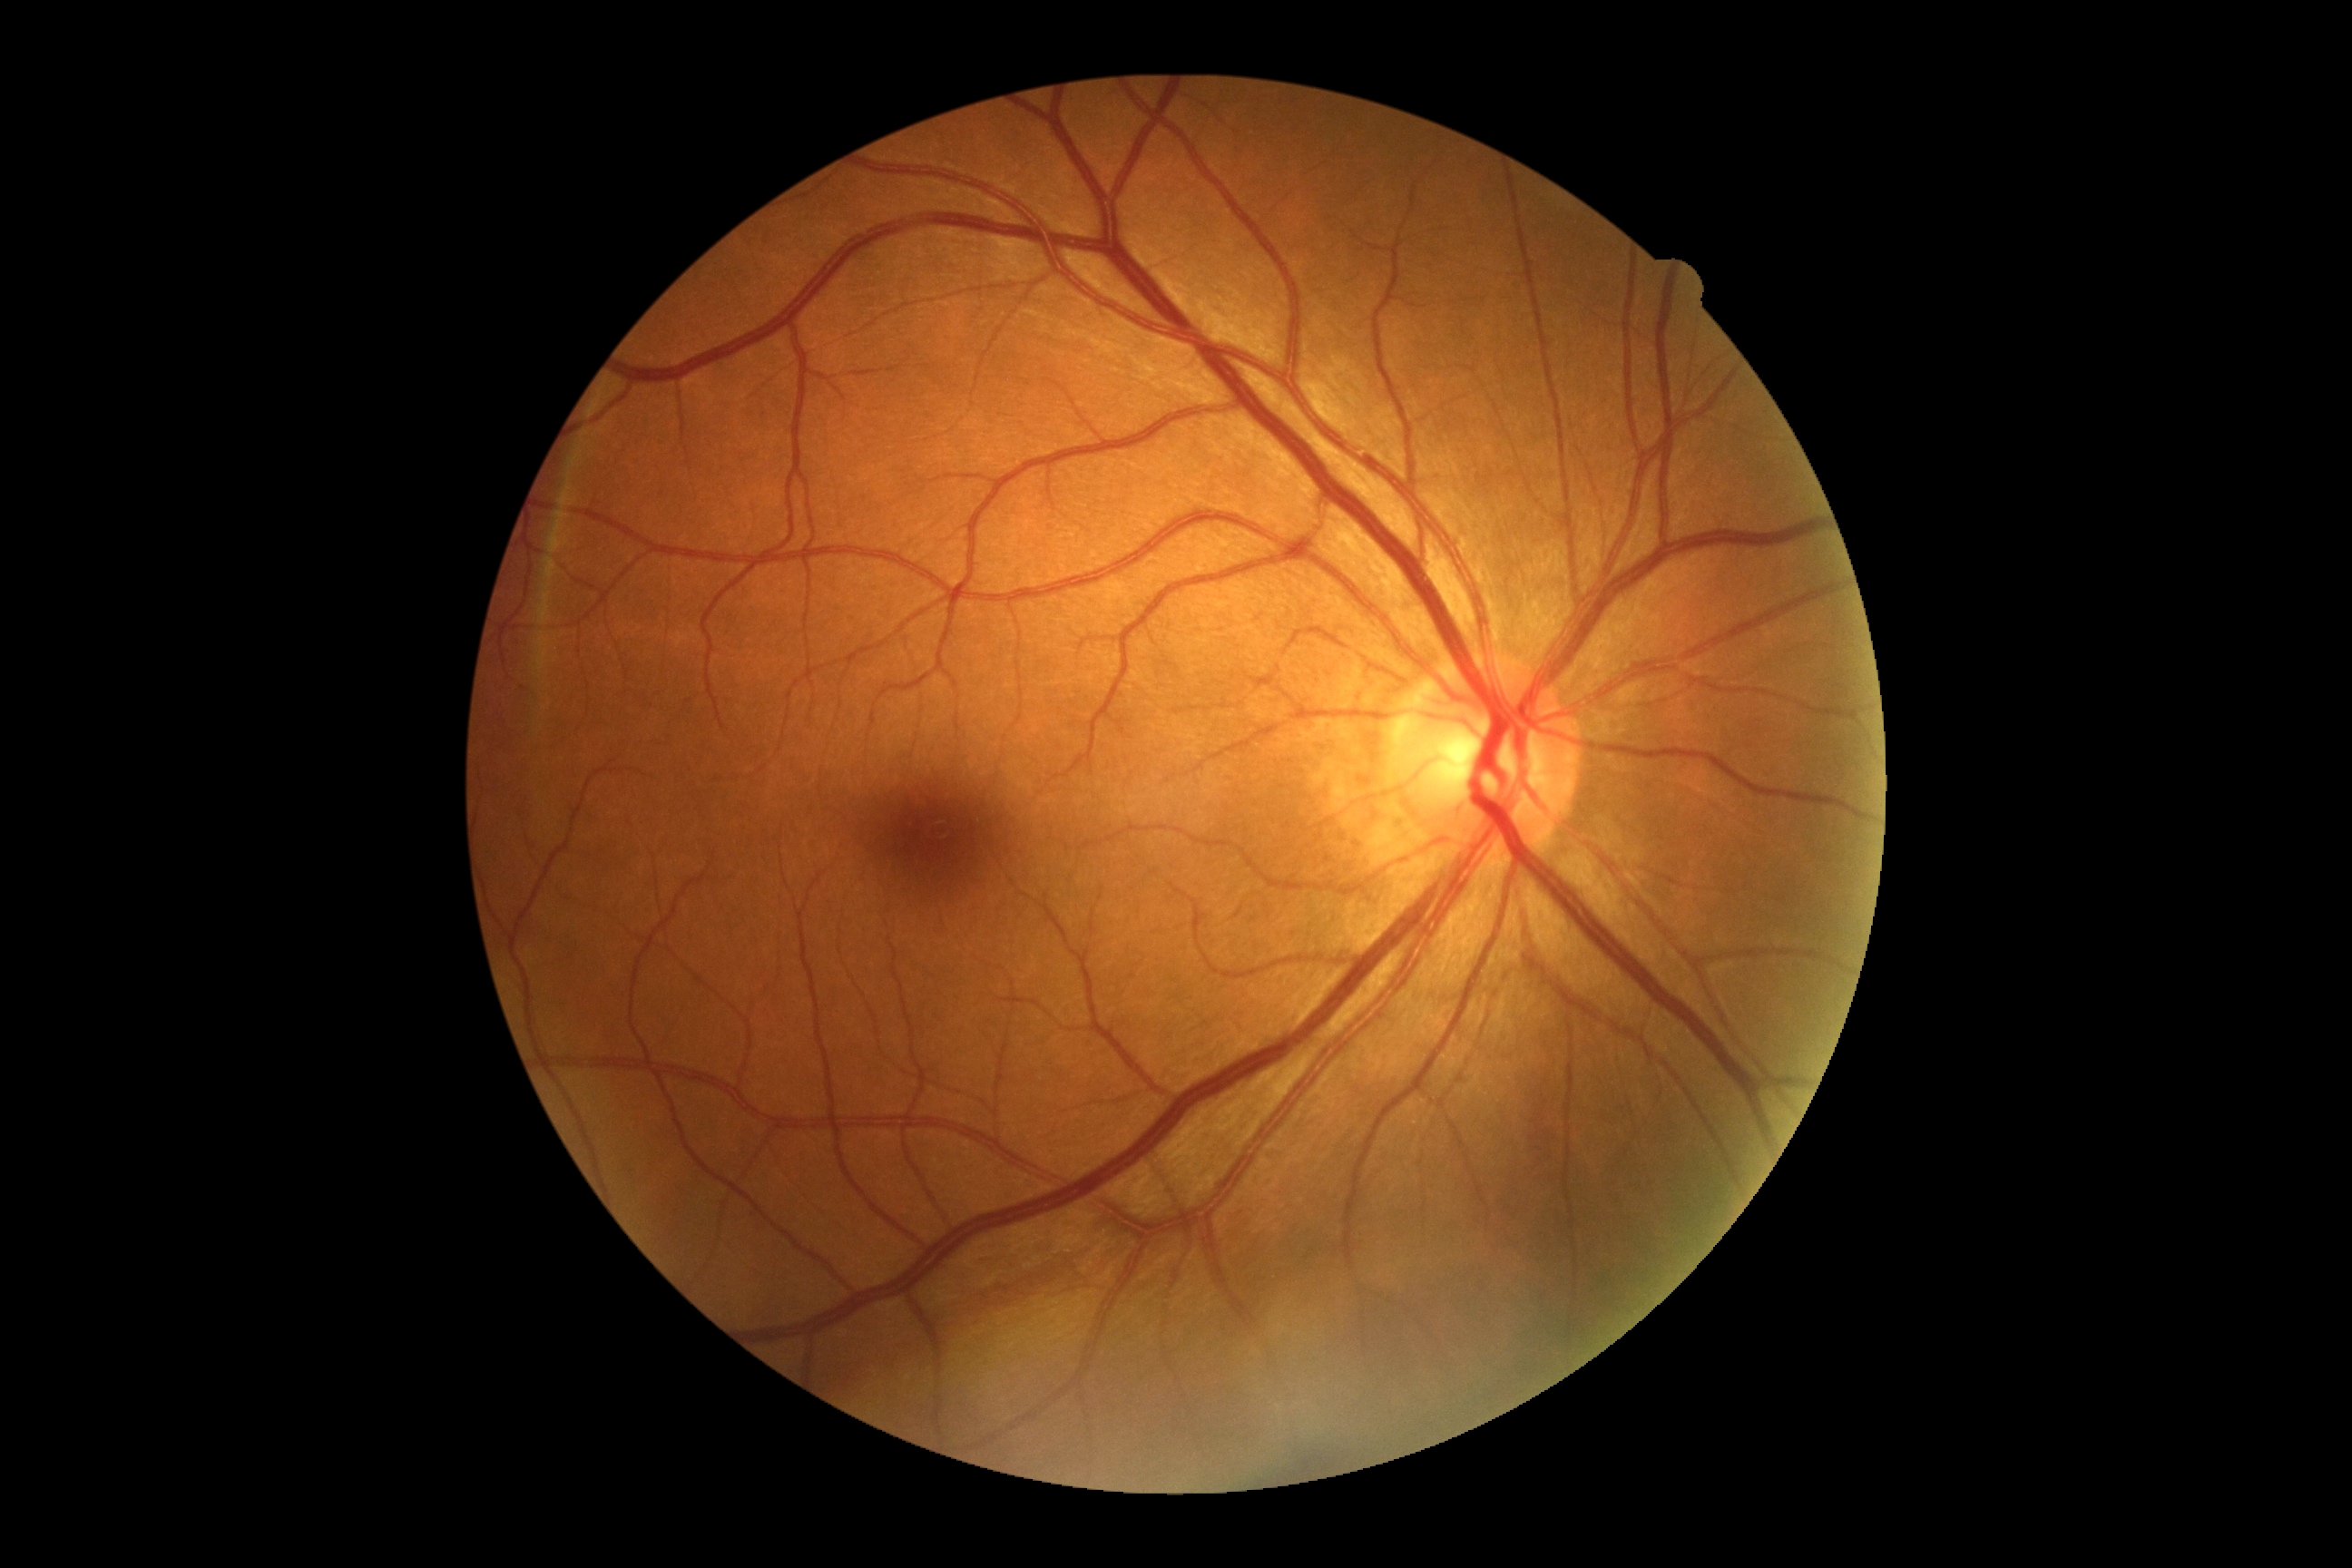

Retinopathy grade: 0. No signs of diabetic retinopathy.